CFP. Graded on the modified Davis scale. NIDEK AFC-230:
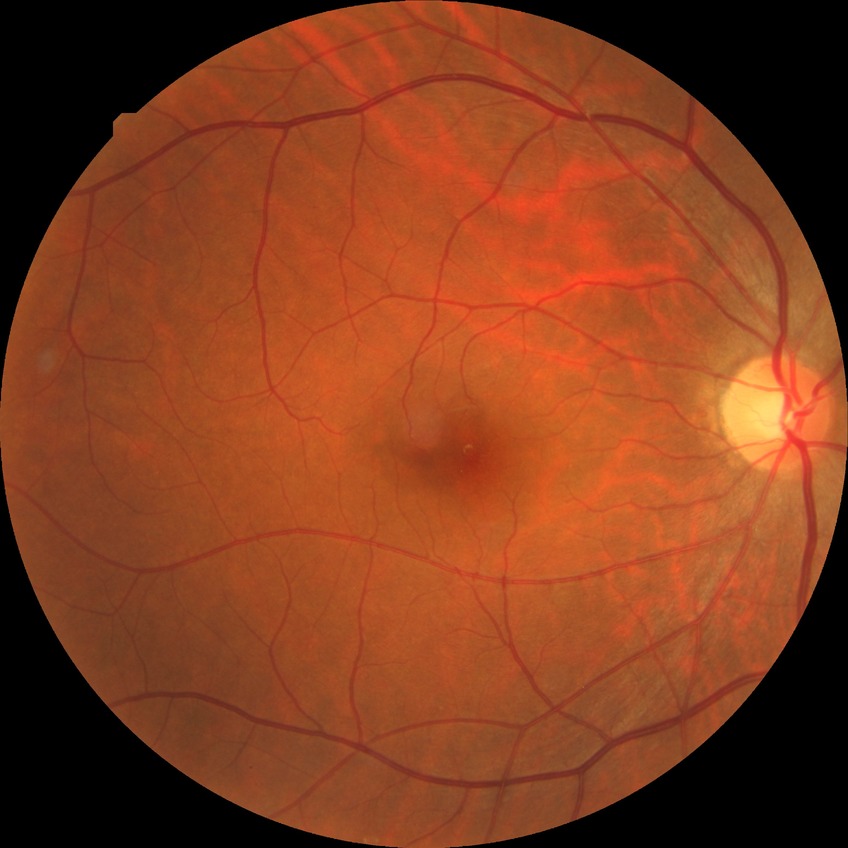 diabetic retinopathy (DR): NDR (no diabetic retinopathy).